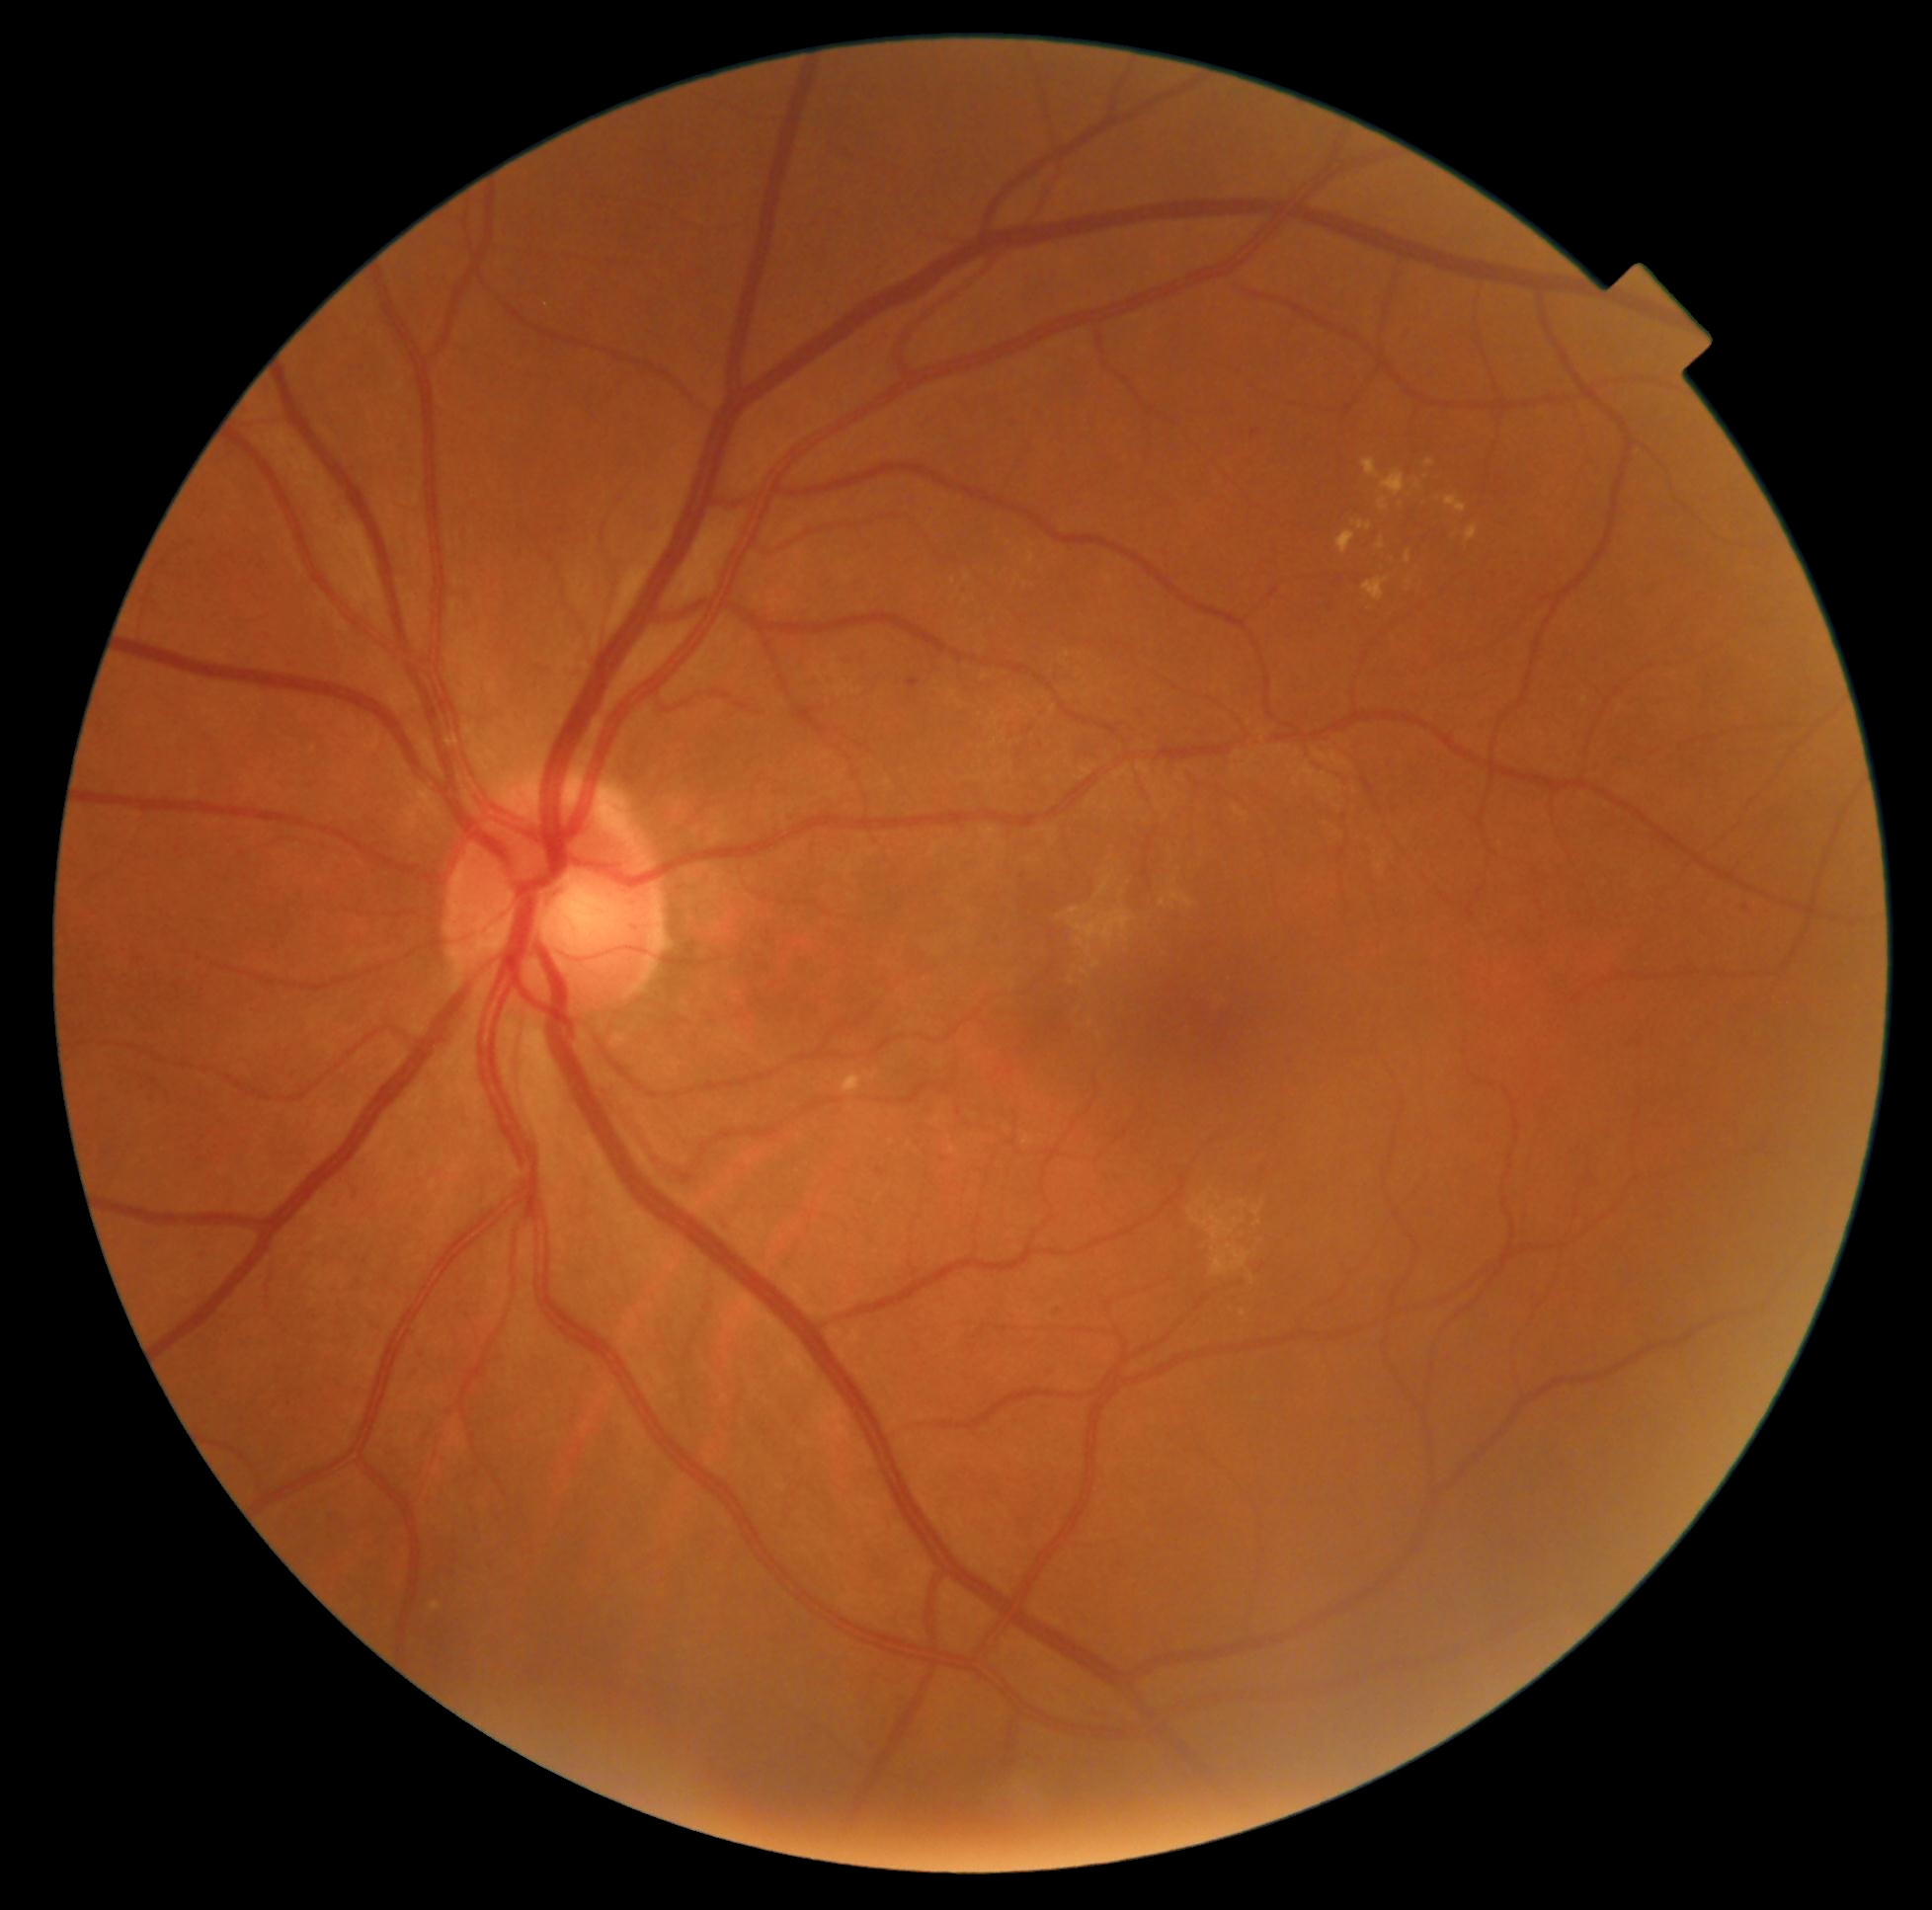
retinopathy = moderate non-proliferative diabetic retinopathy (grade 2).